89-year-old patient · intraocular pressure (IOP) 13 mmHg · optic disc-centered — 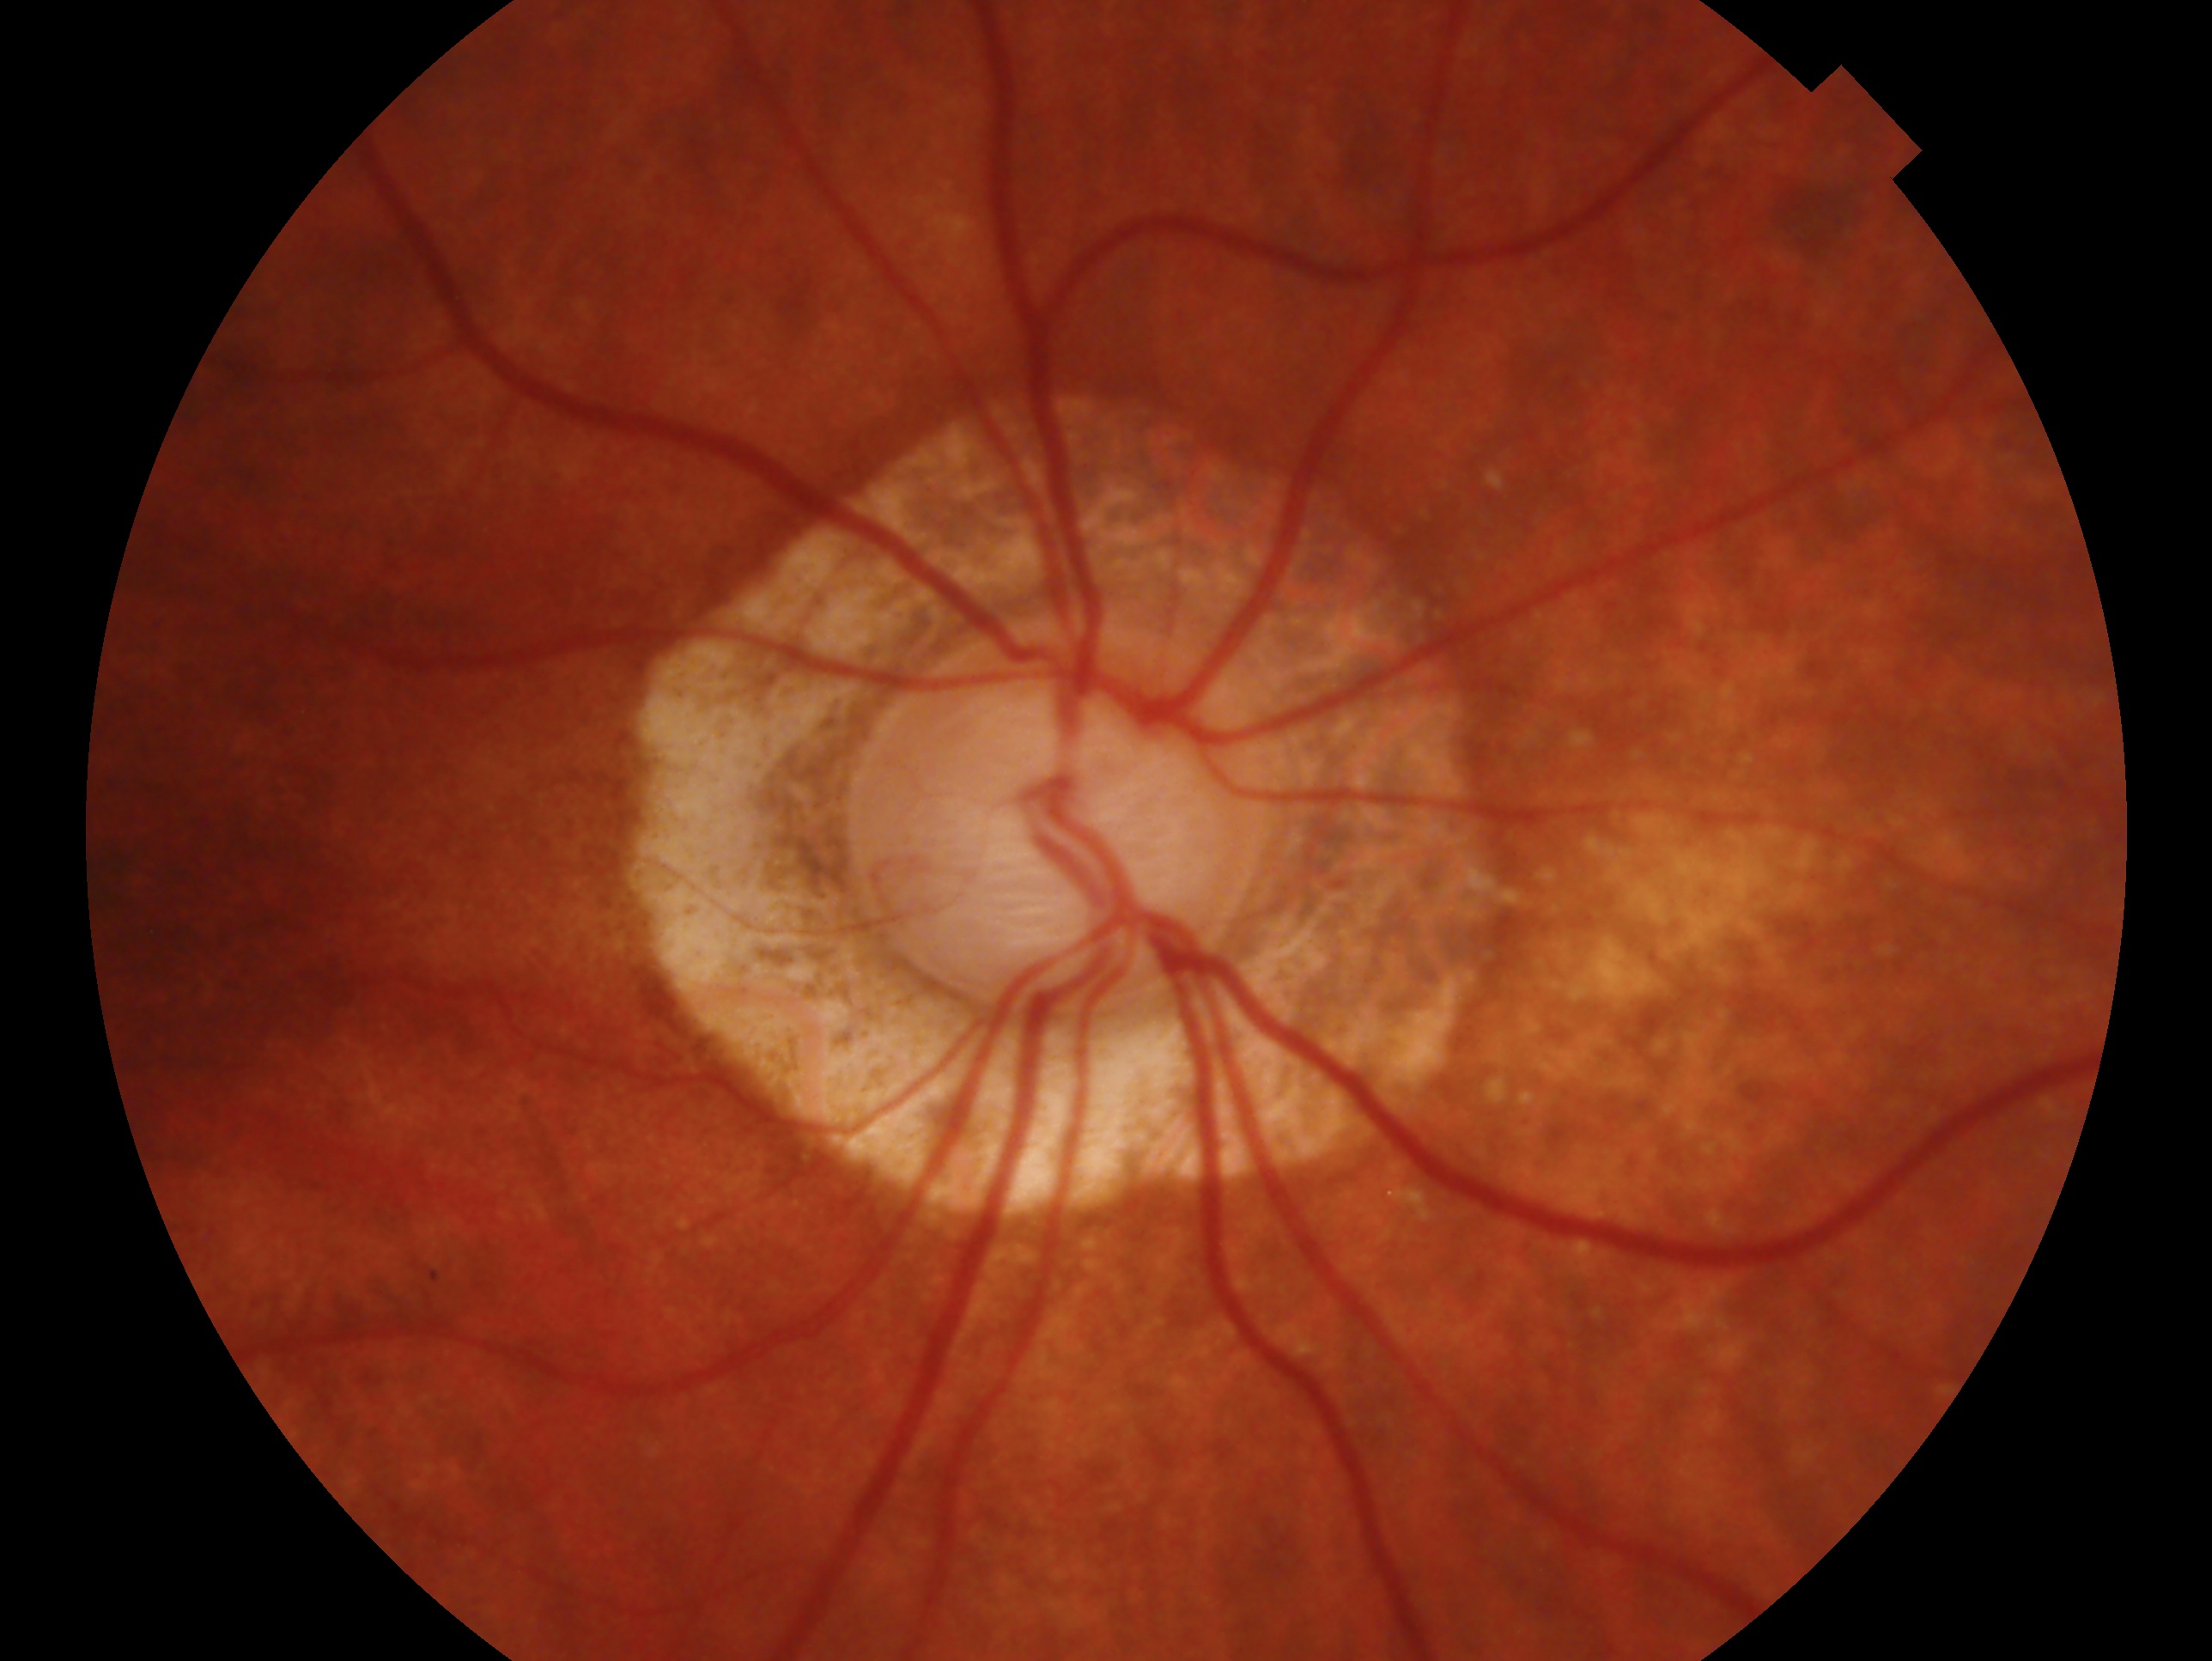

Glaucoma diagnosis — glaucomatous.
This is the OD.